FOV: 45 degrees: 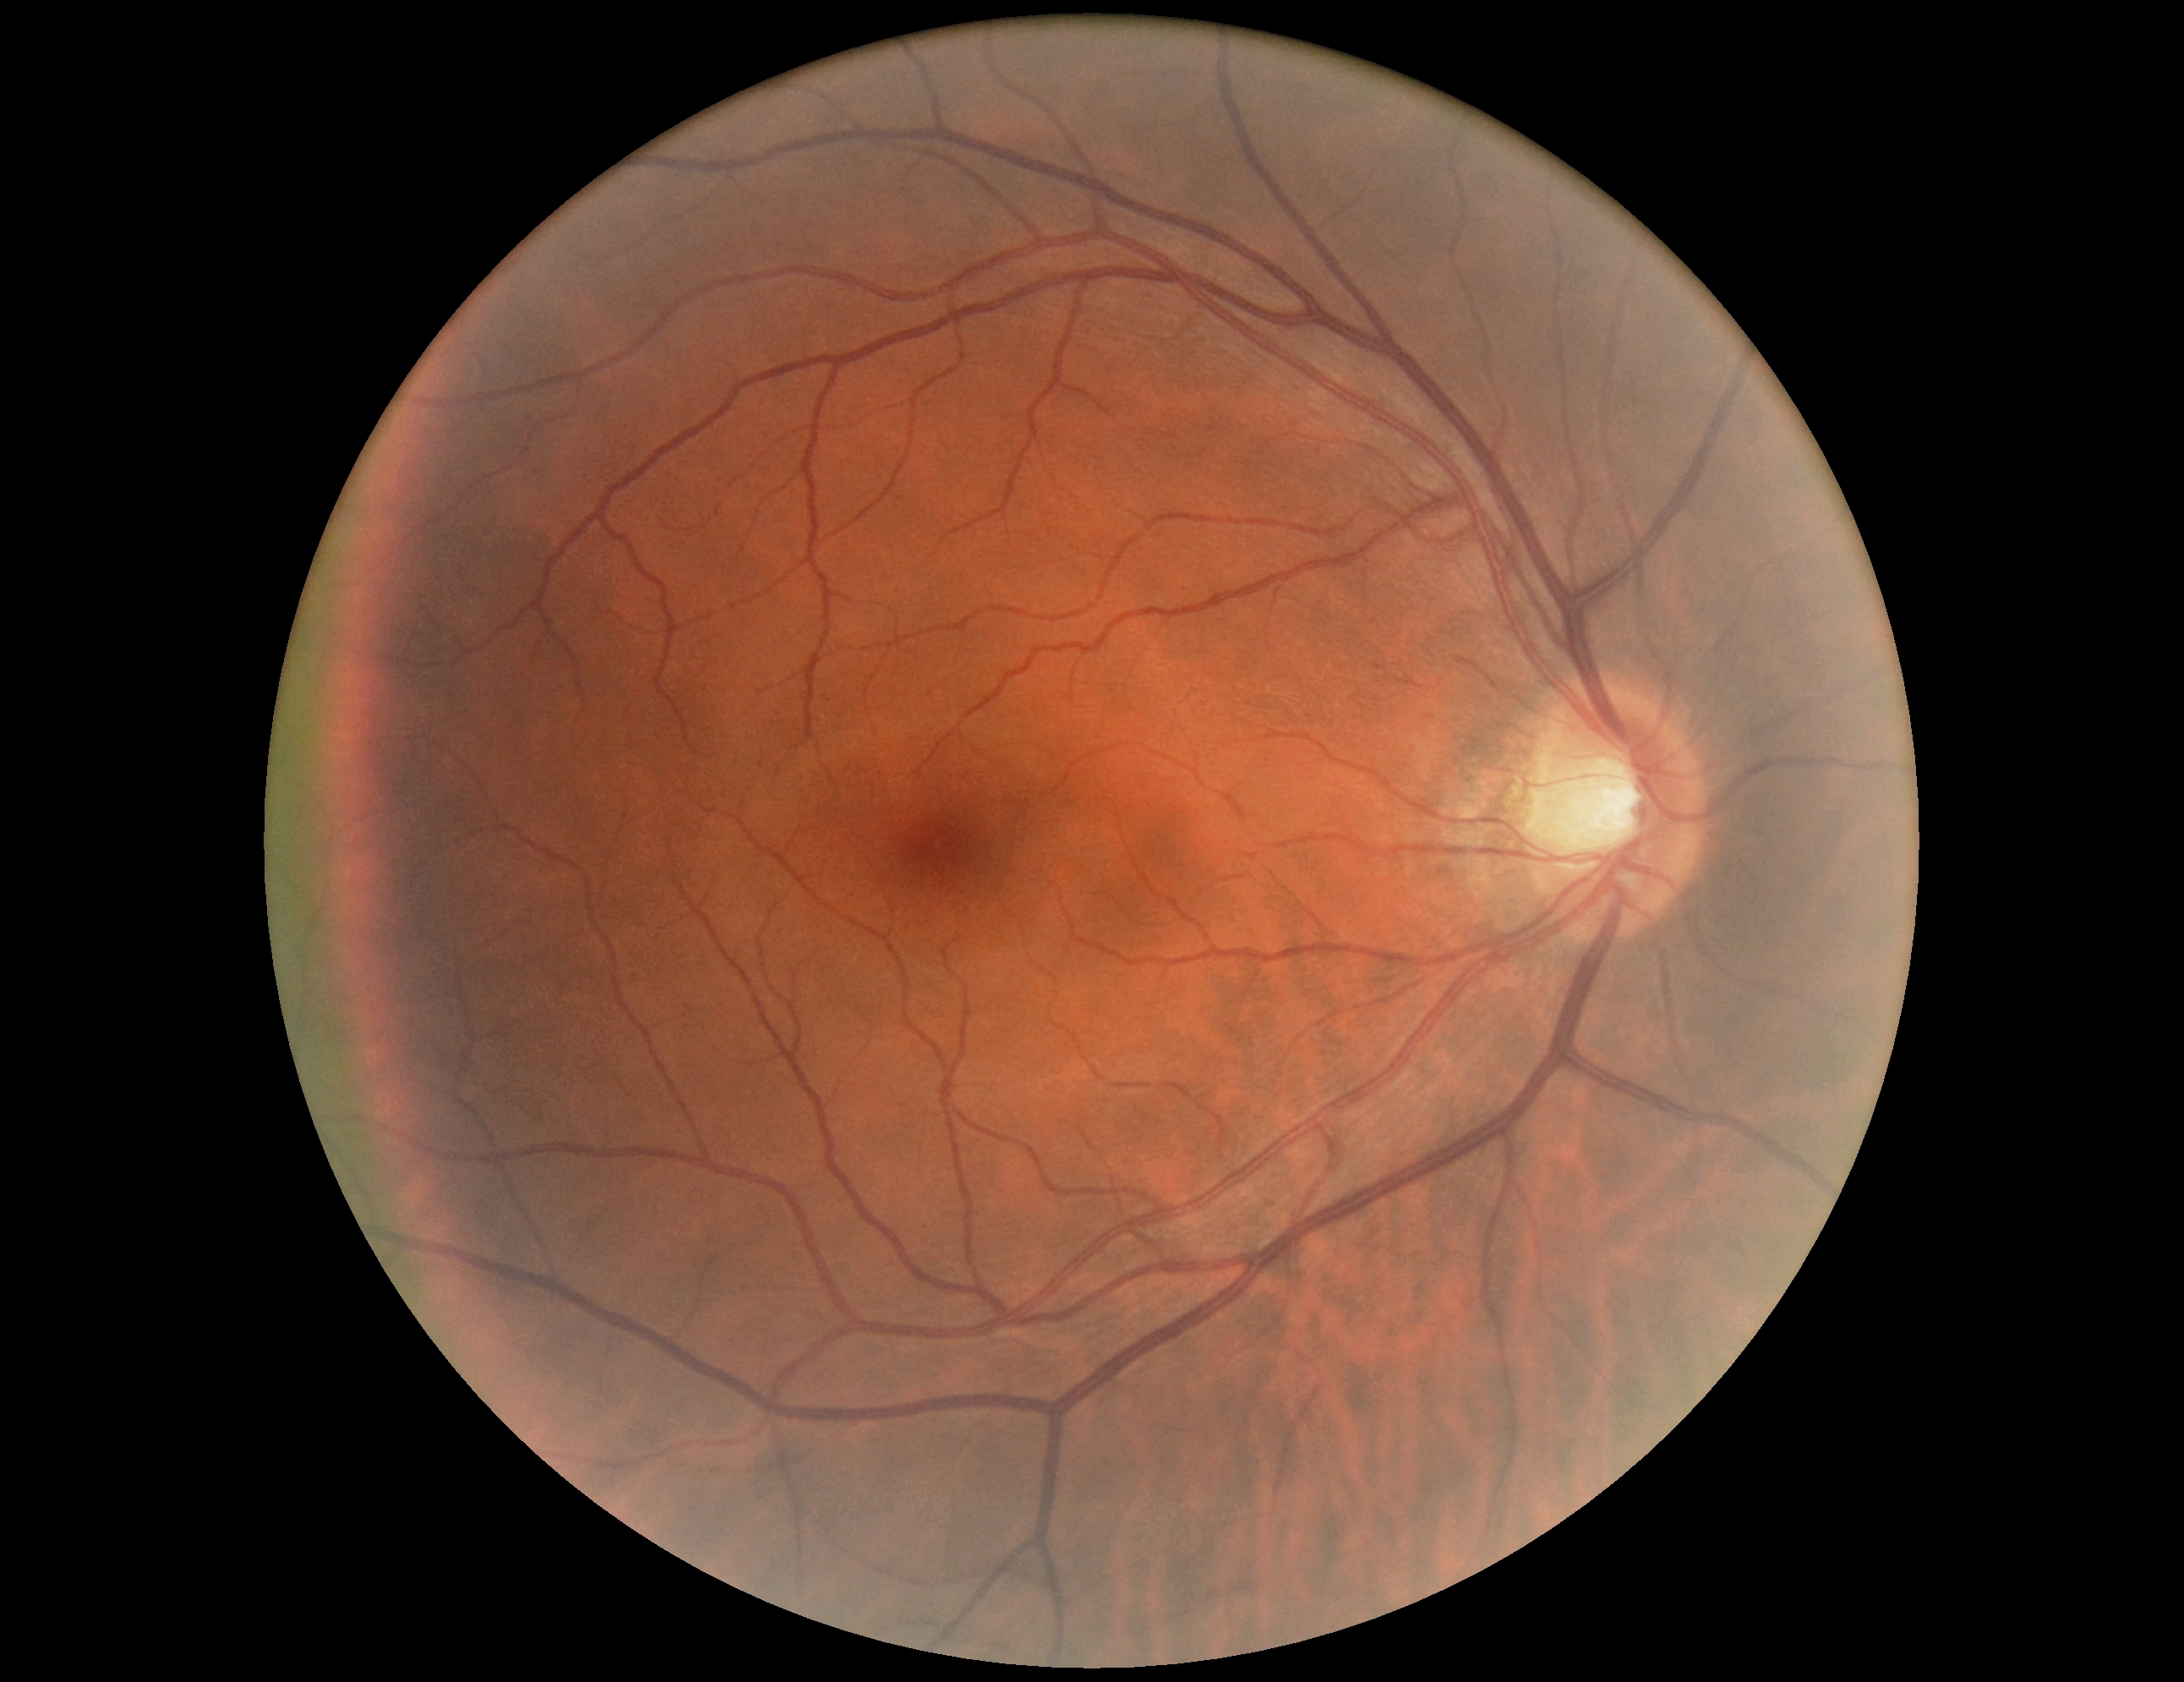 DR: grade 0 (no apparent retinopathy).